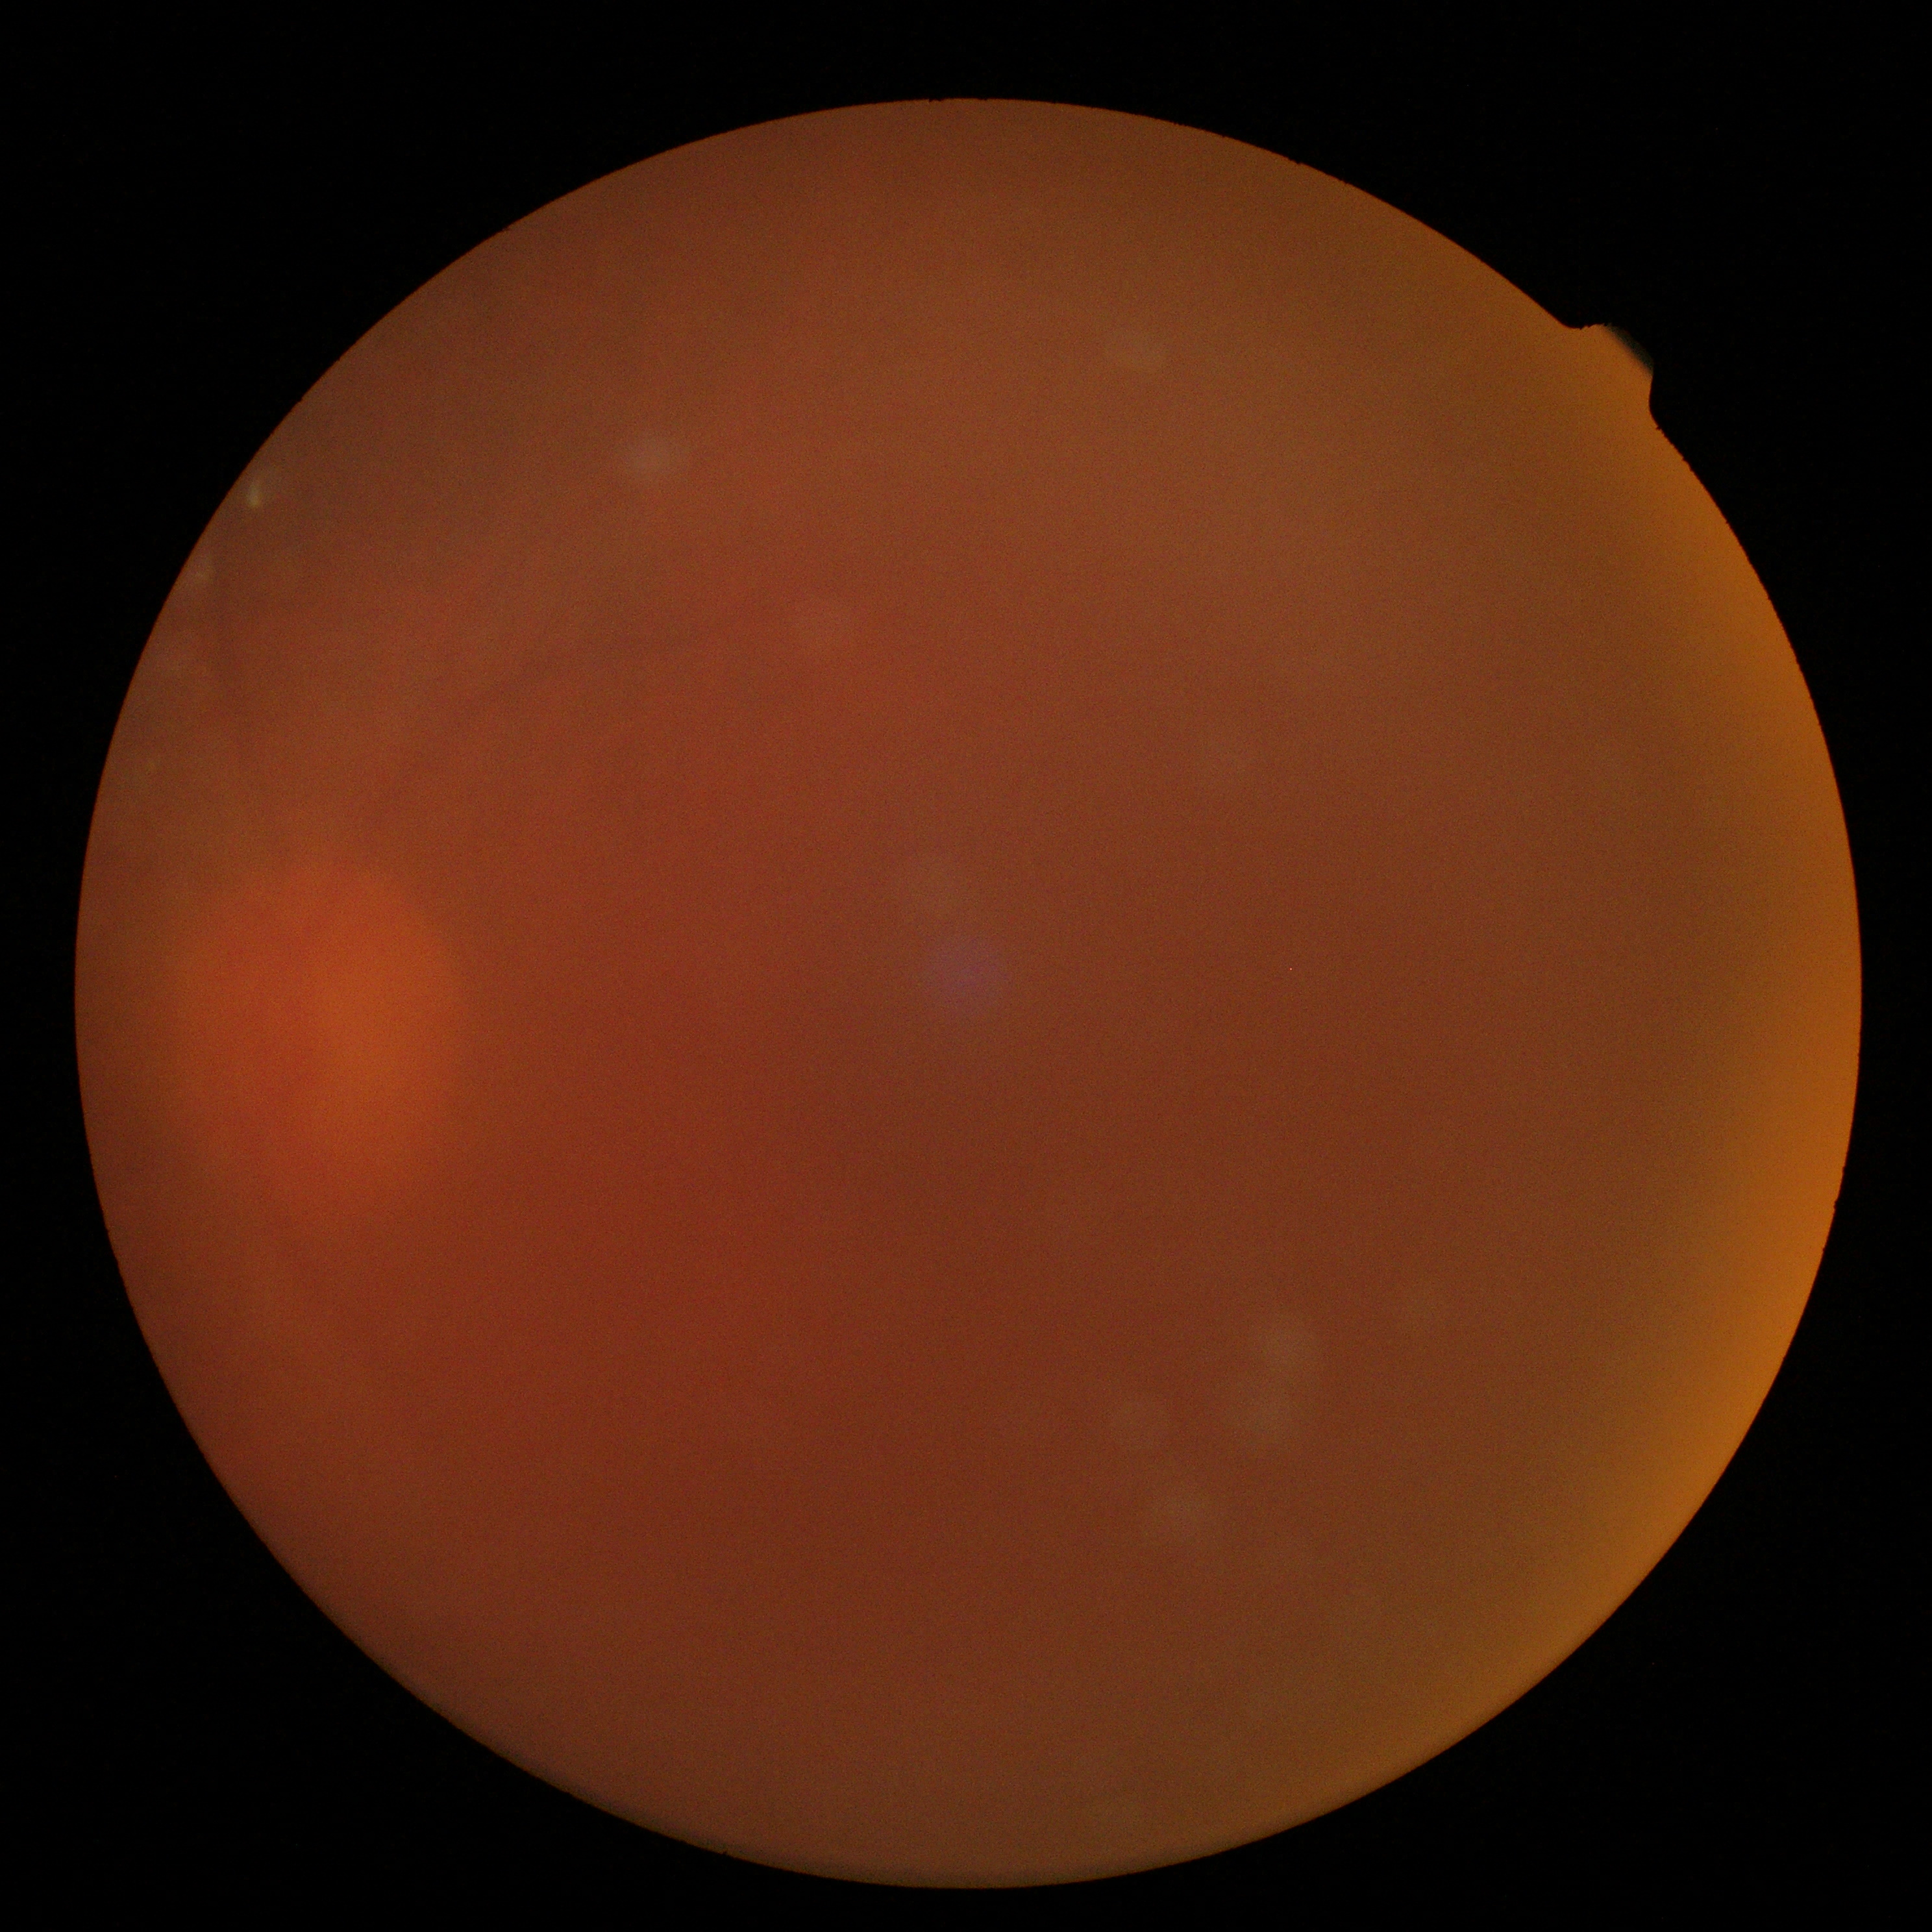 The image cannot be graded for diabetic retinopathy. DR severity: ungradable due to poor image quality.